Camera: NIDEK AFC-230 · modified Davis classification — 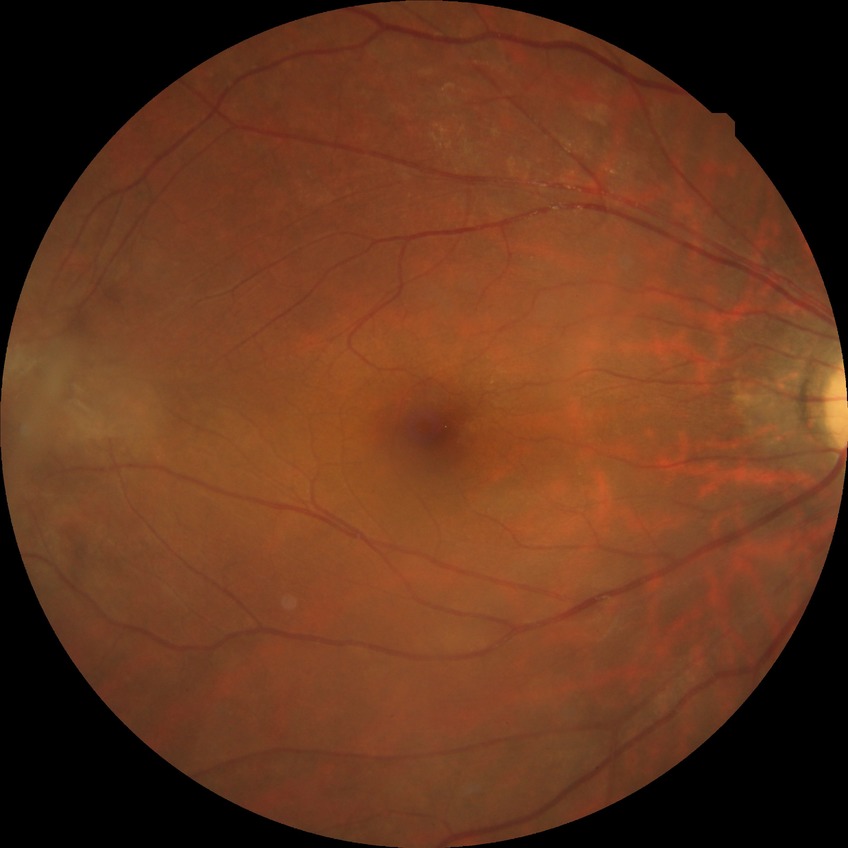

Retinopathy grade: no diabetic retinopathy.